2352 by 1568 pixels
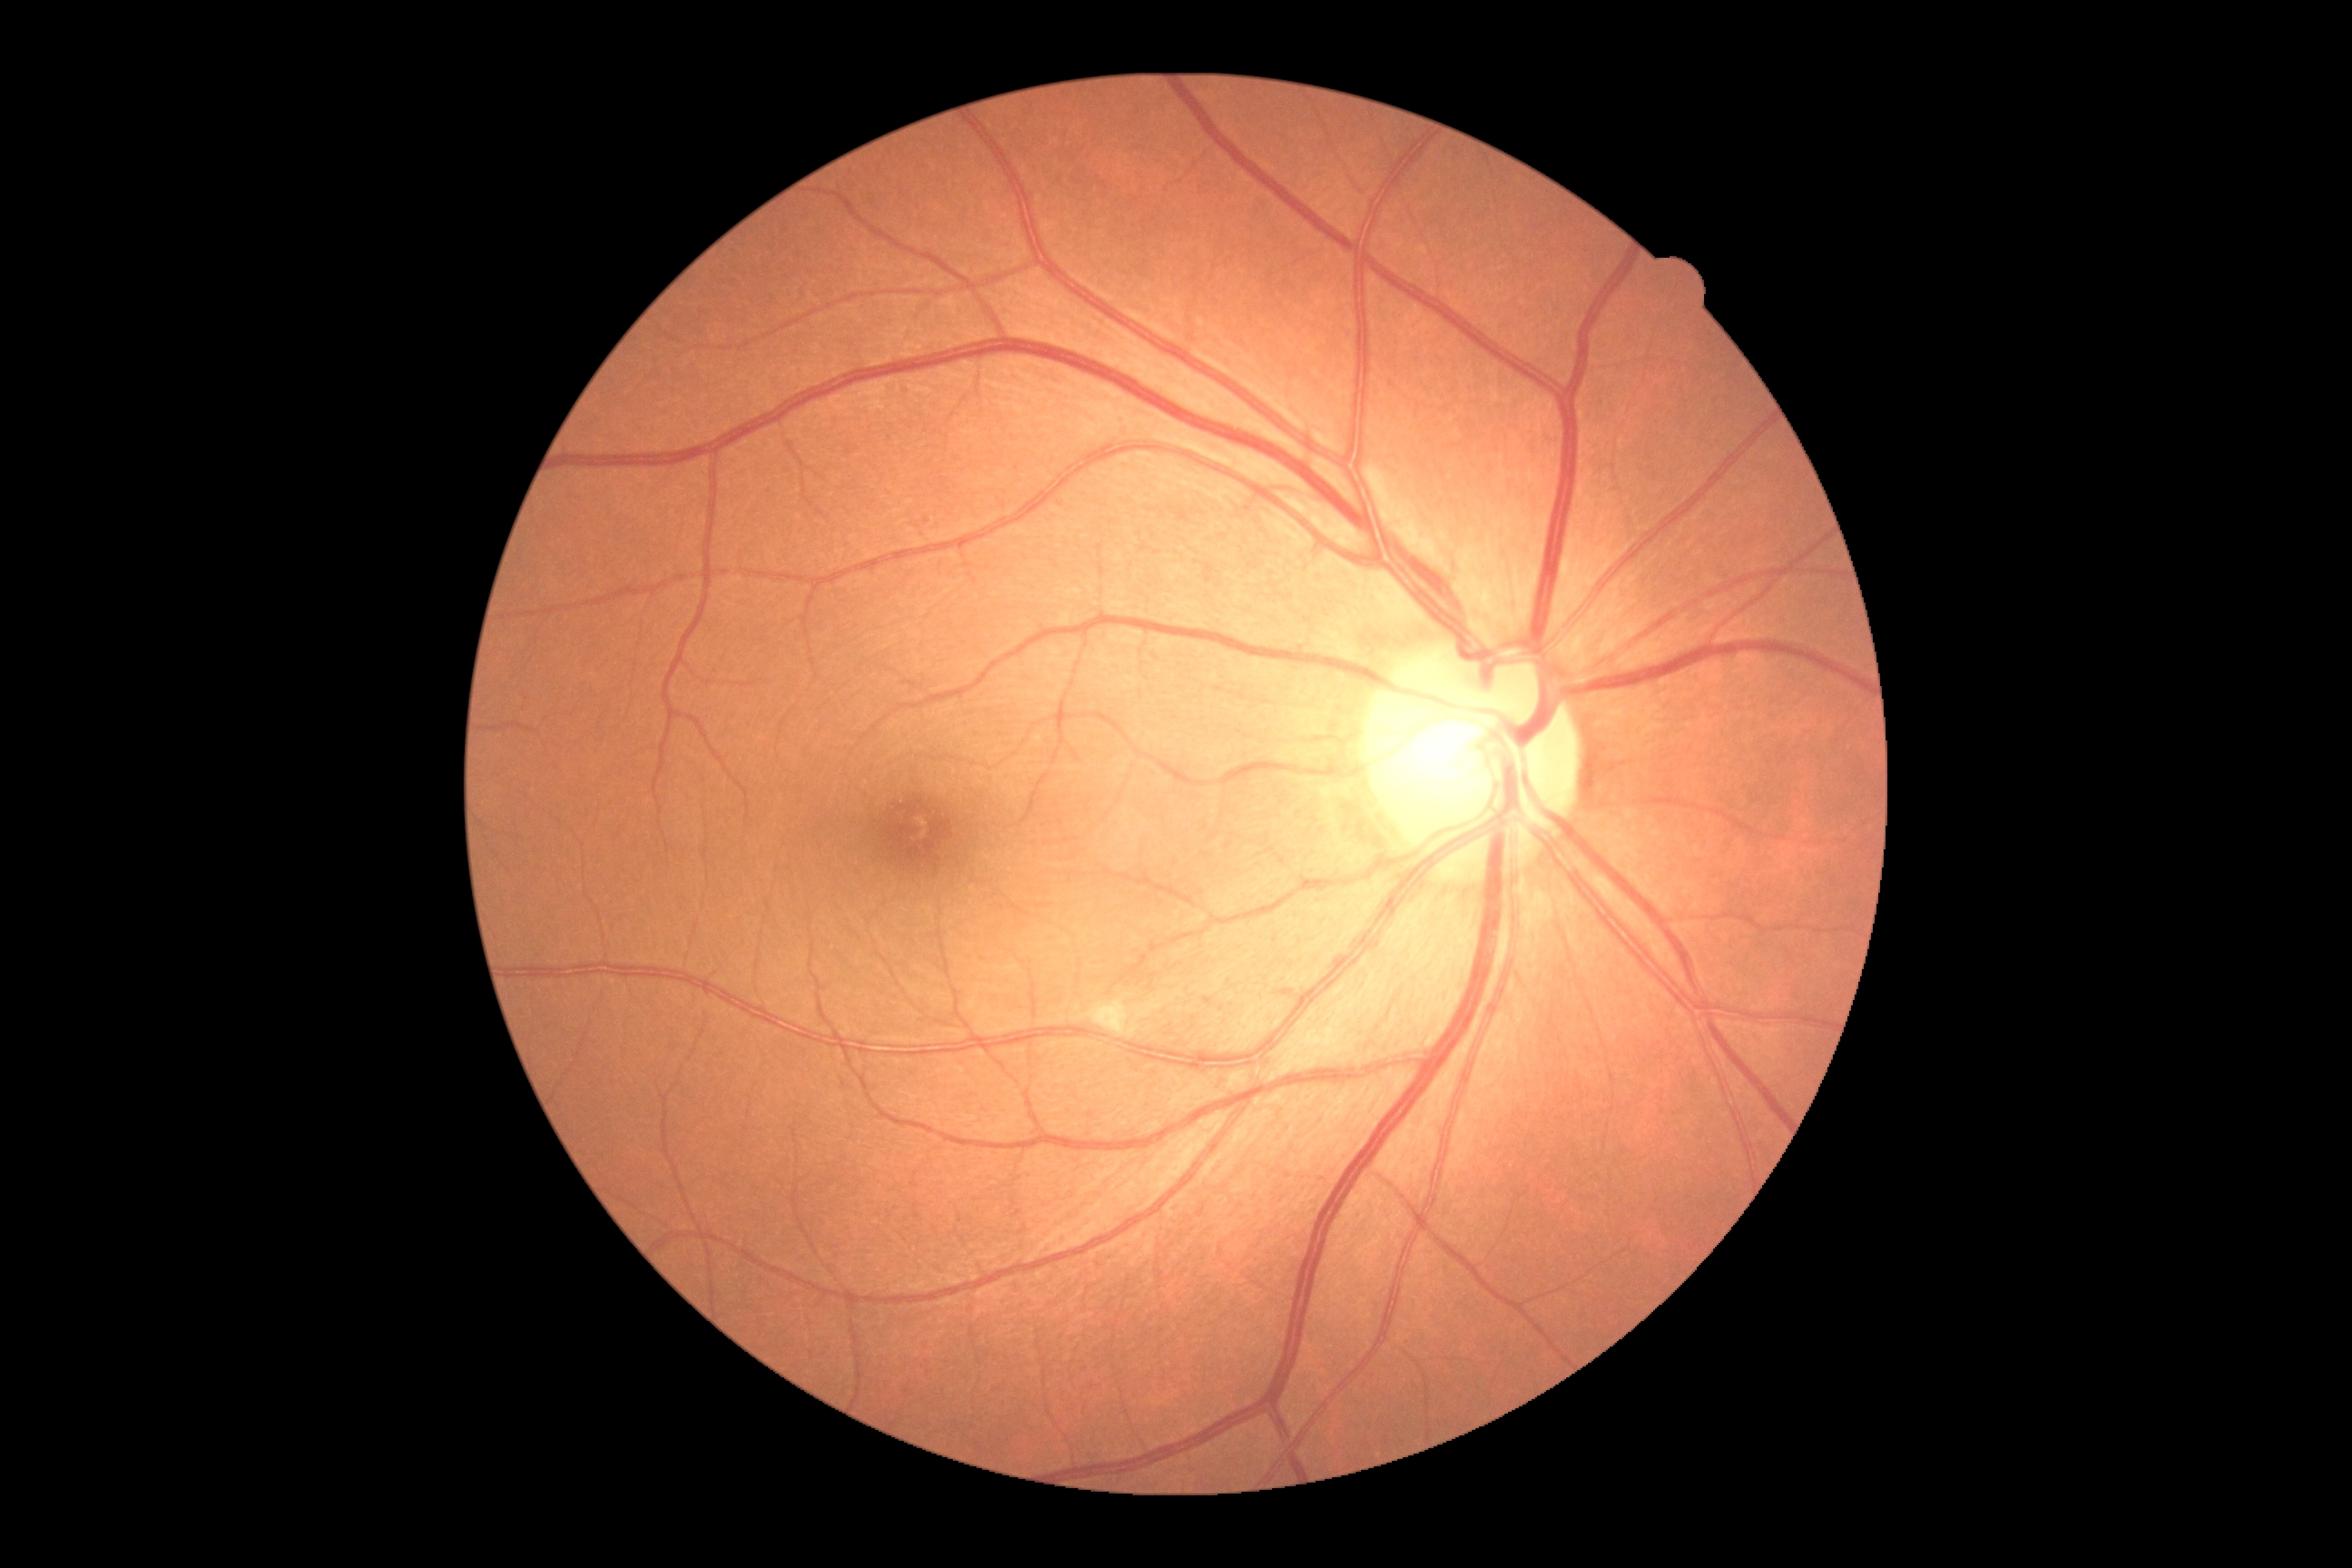 DR stage is moderate non-proliferative diabetic retinopathy (grade 2).